FOV: 45 degrees:
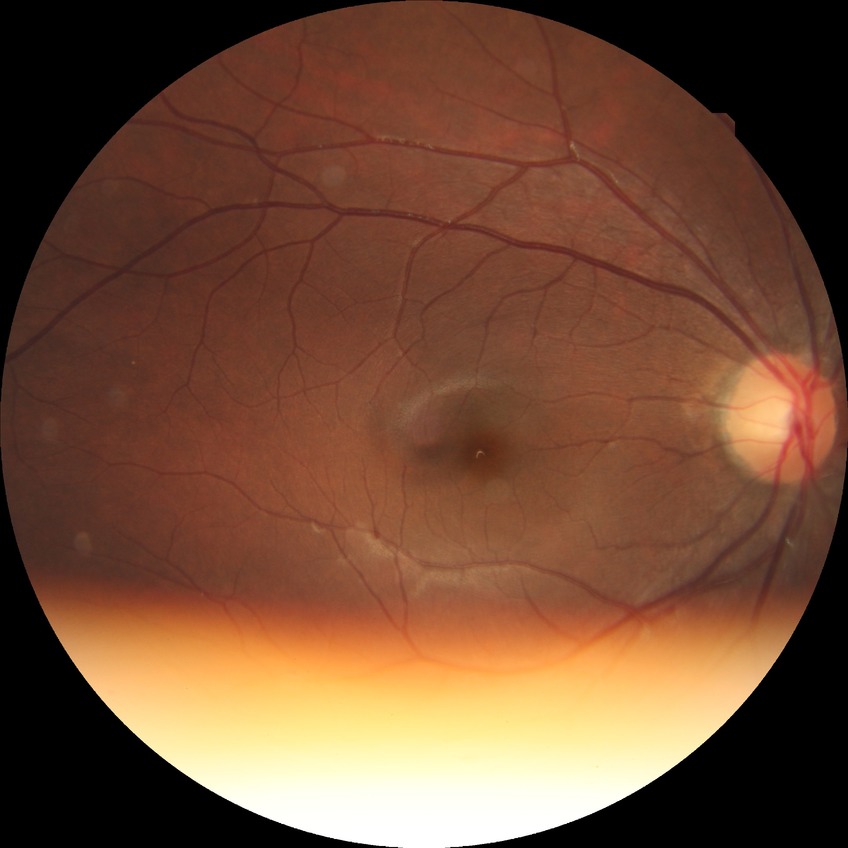

Diabetic retinopathy (DR) is NDR (no diabetic retinopathy).